RetCam wide-field infant fundus image
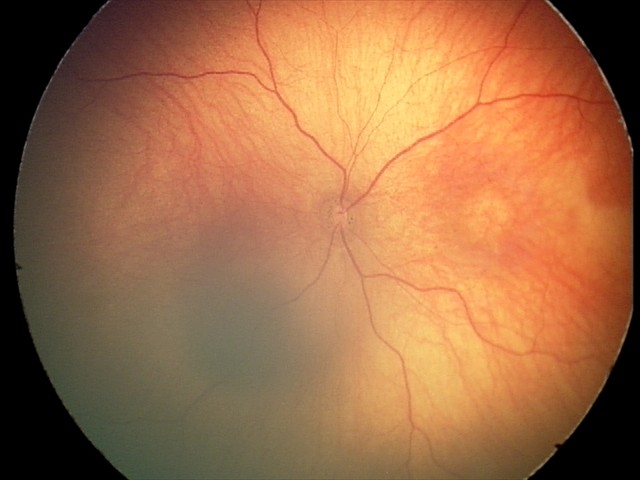
Screening examination with no abnormal retinal findings.